Acquired with a NIDEK AFC-230, posterior pole photograph — 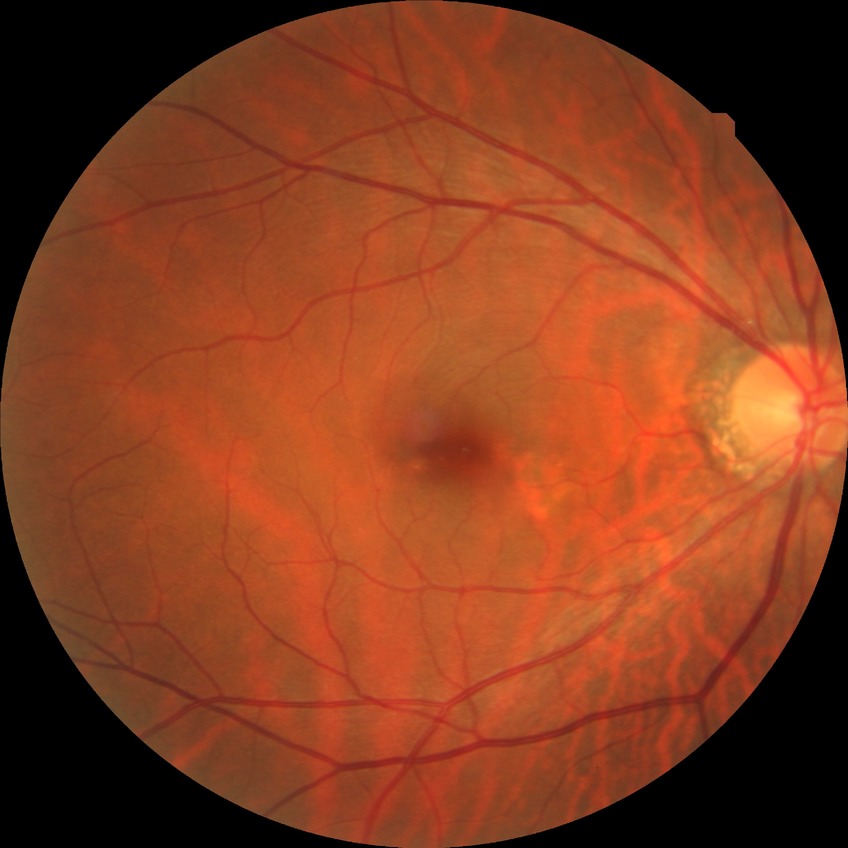
Diabetic retinopathy (DR) is no diabetic retinopathy (NDR).